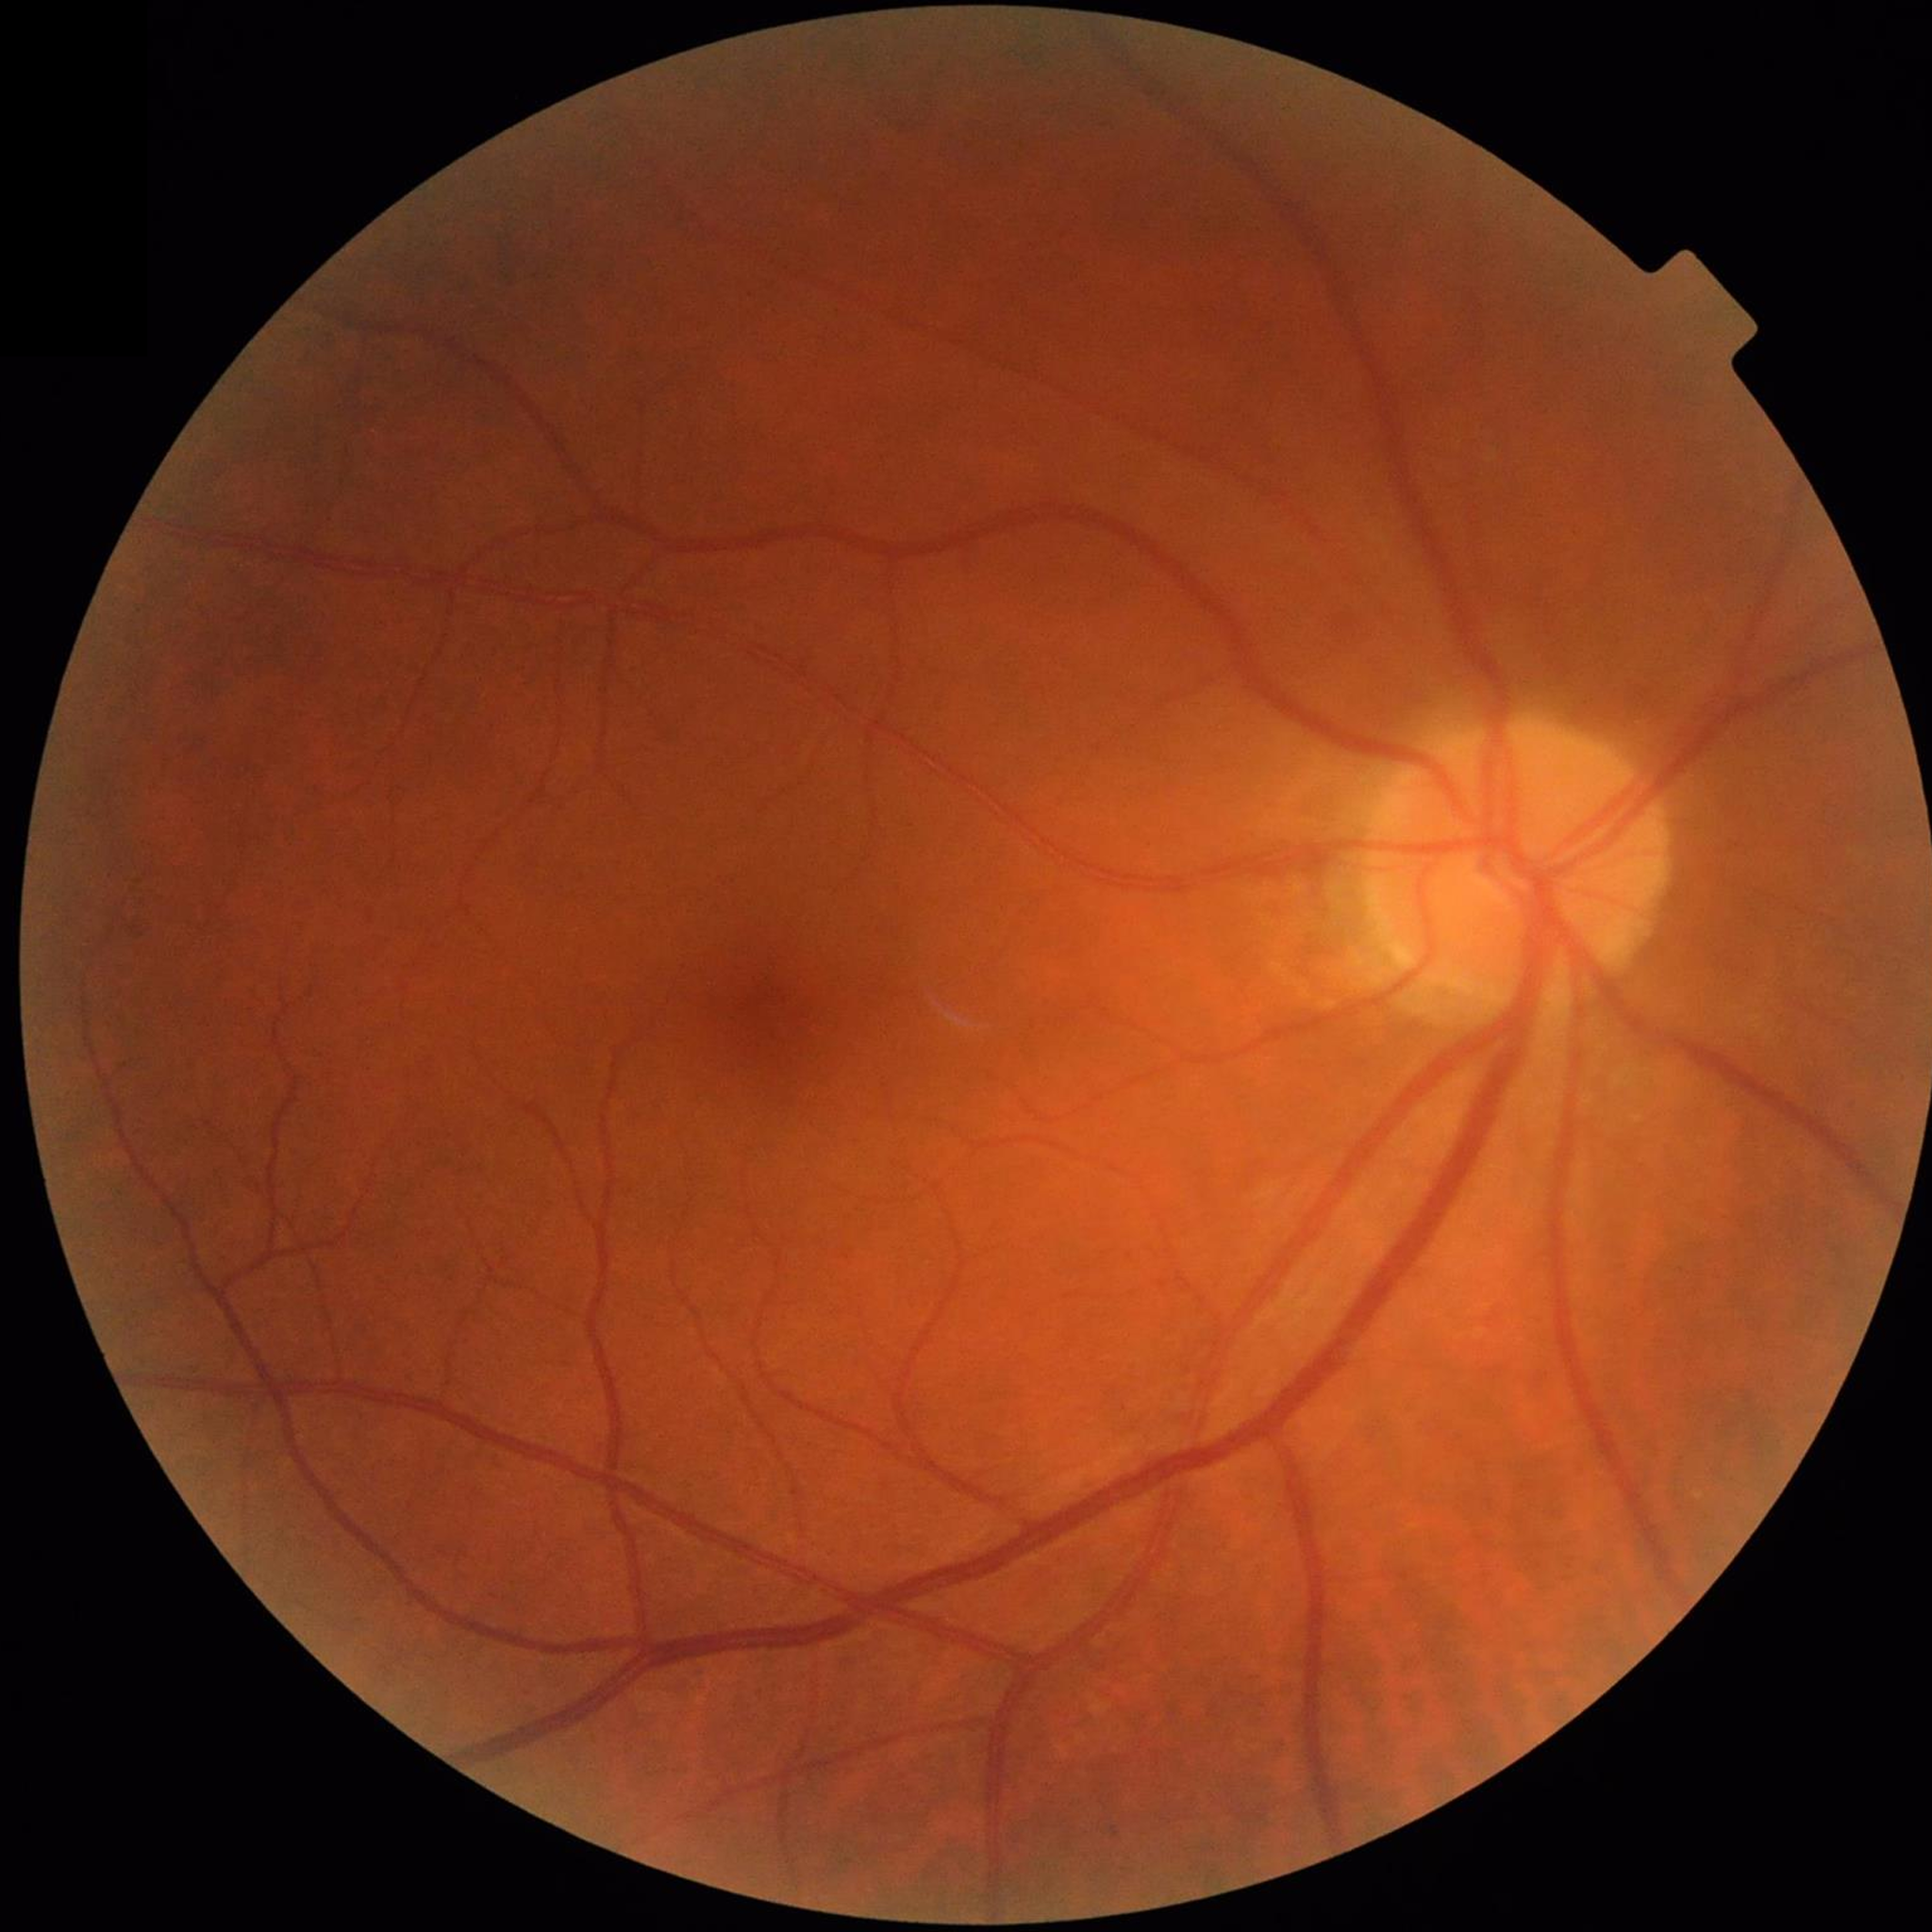

Diagnosis: no AMD, diabetic retinopathy, or glaucoma